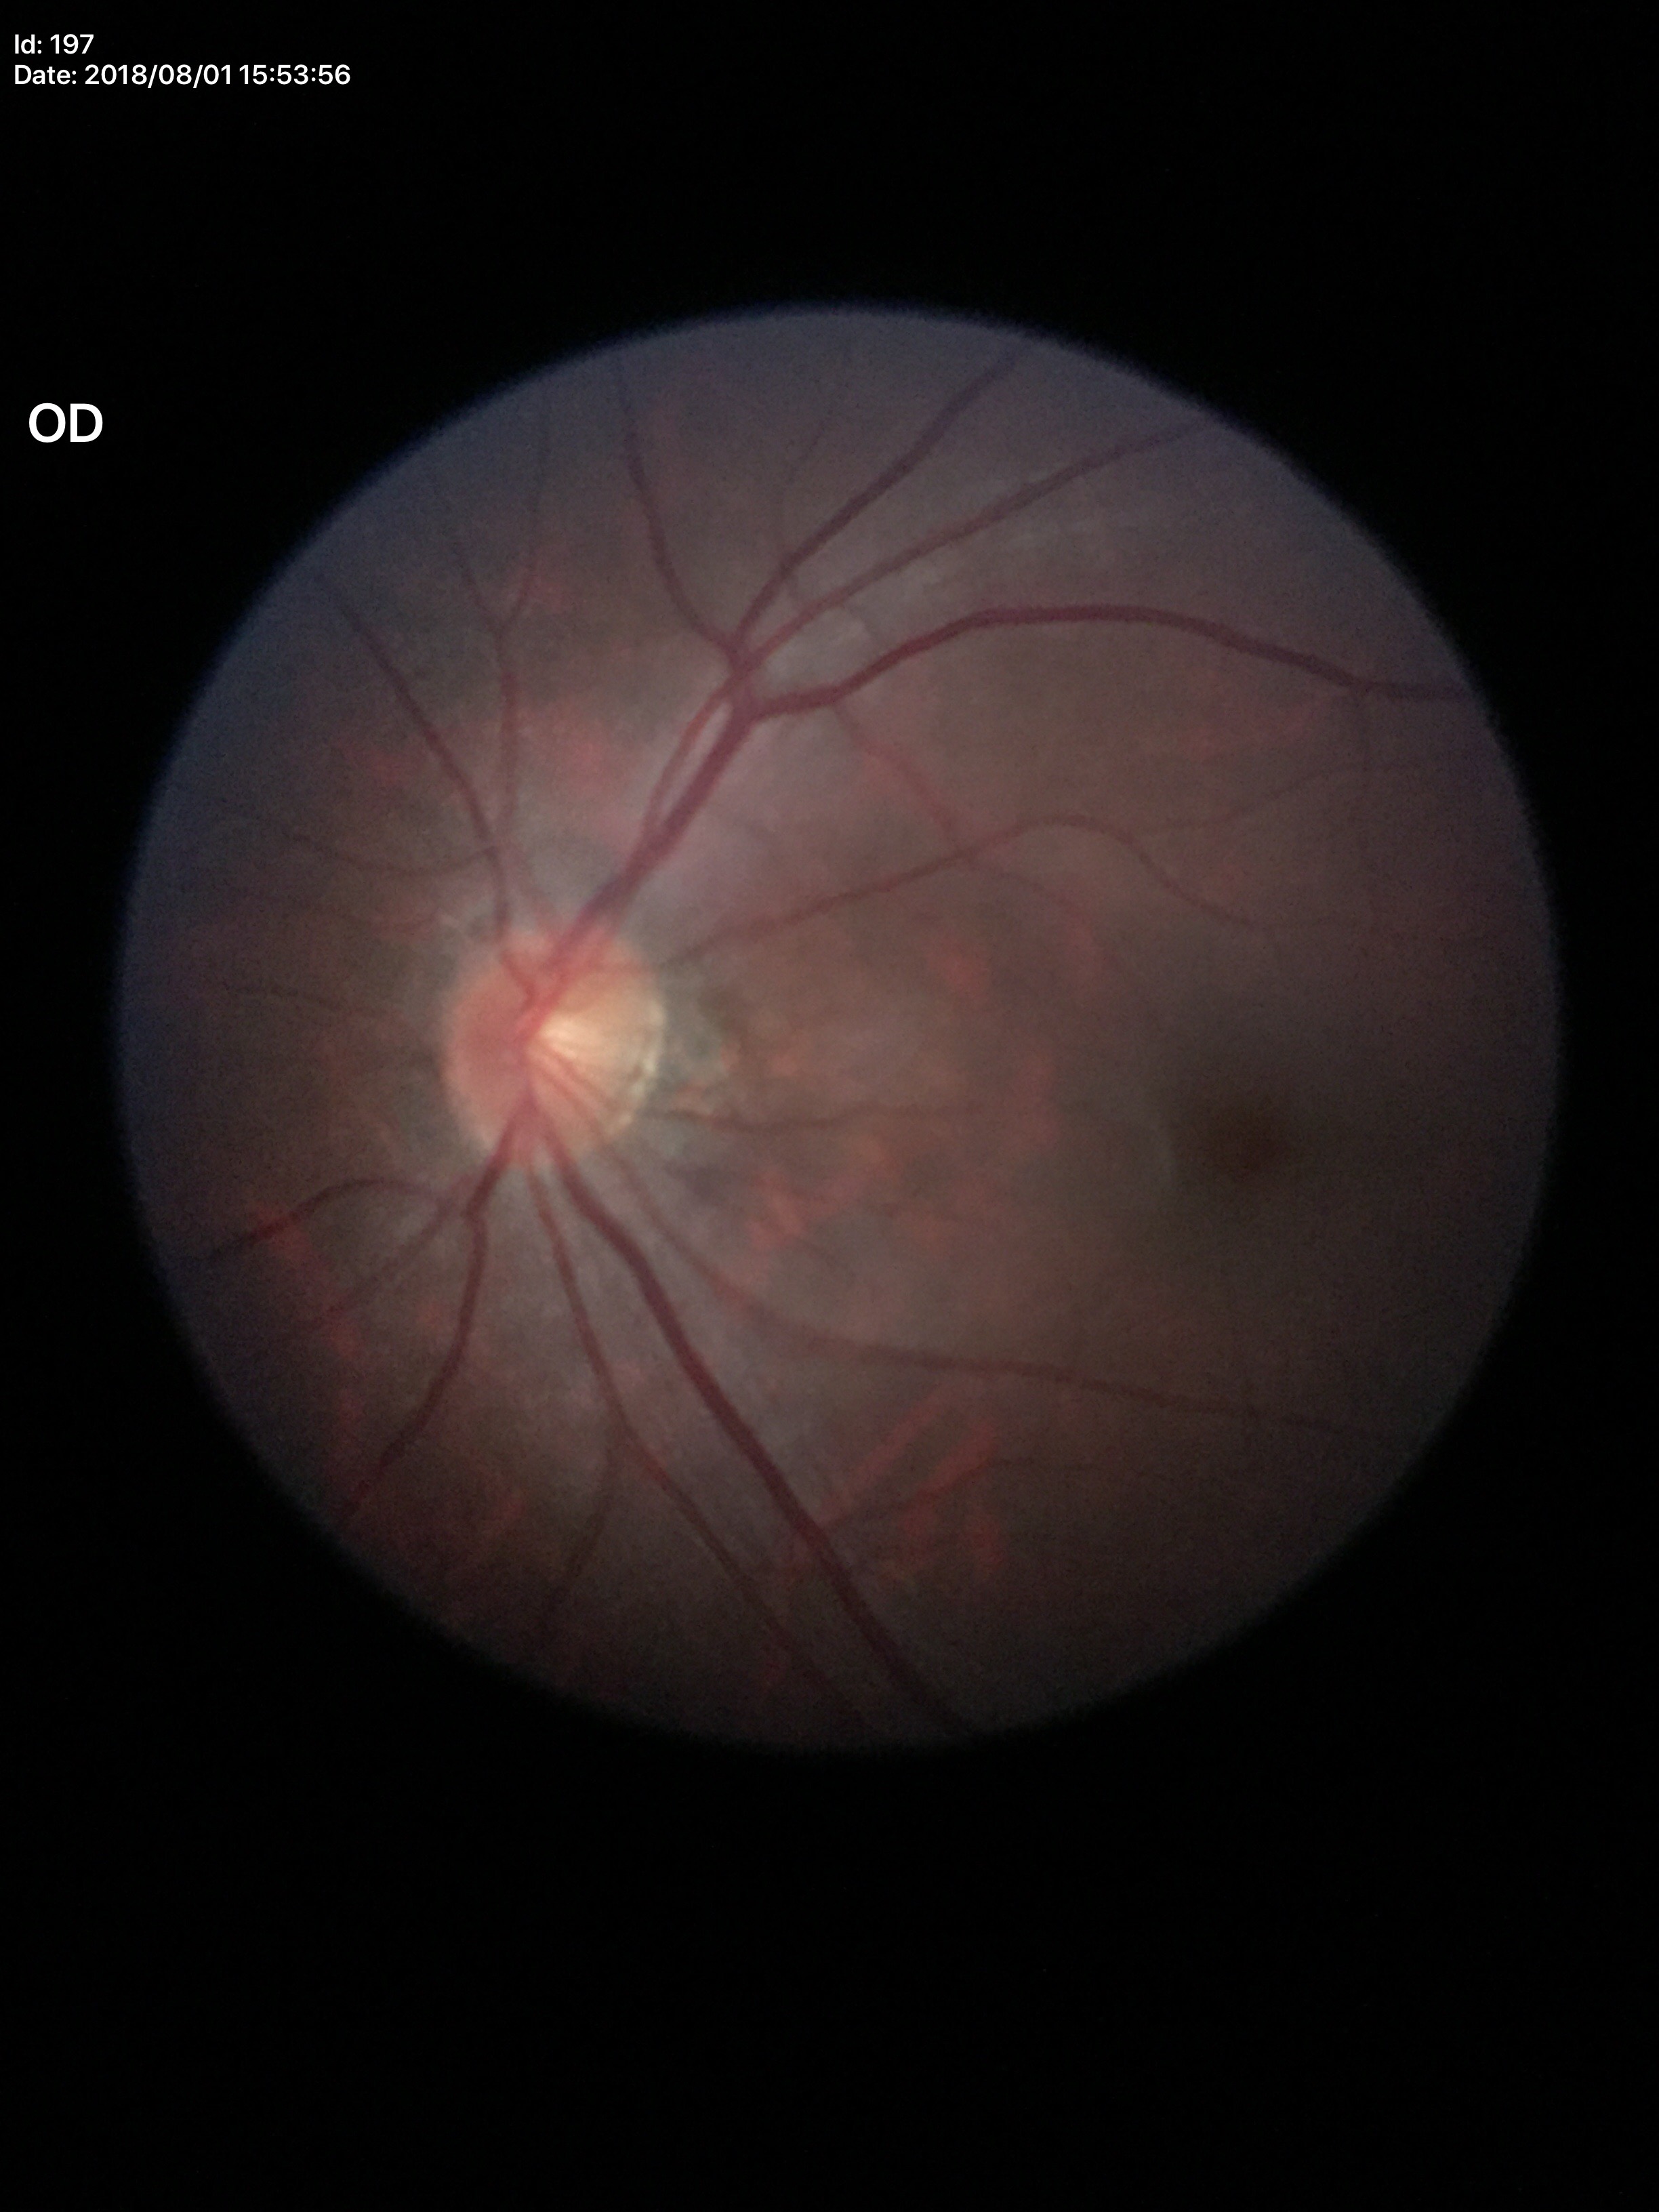 No signs of glaucoma.
Vertical CDR (VCDR): 0.48.
Horizontal C/D ratio (HCDR) is 0.49.